Posterior pole photograph: 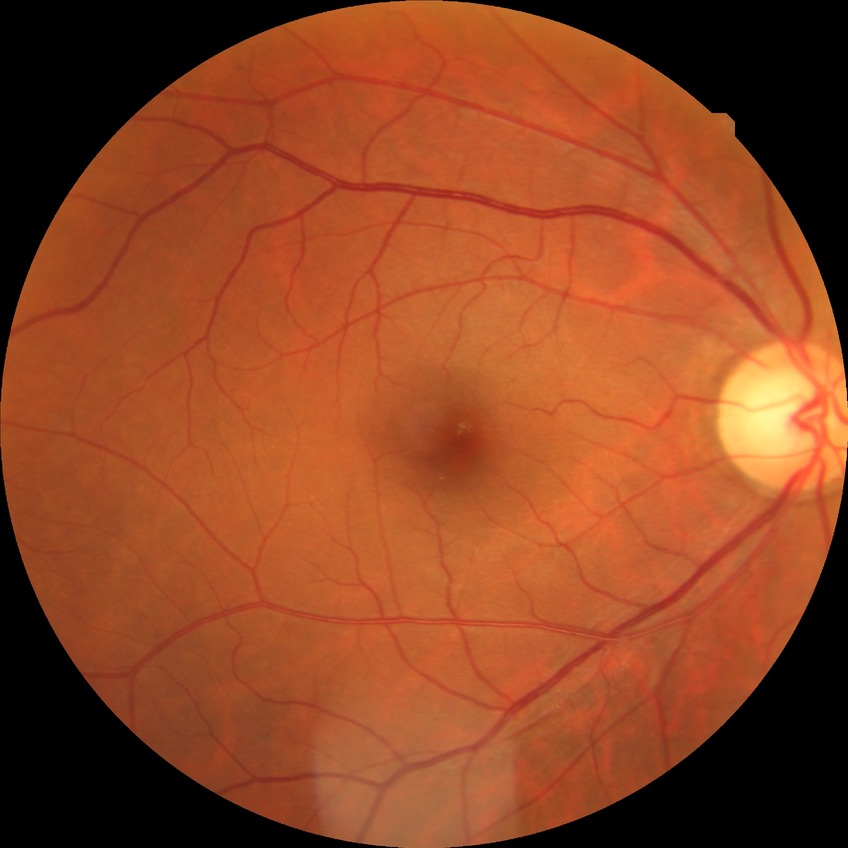

Diabetic retinopathy severity is no diabetic retinopathy.